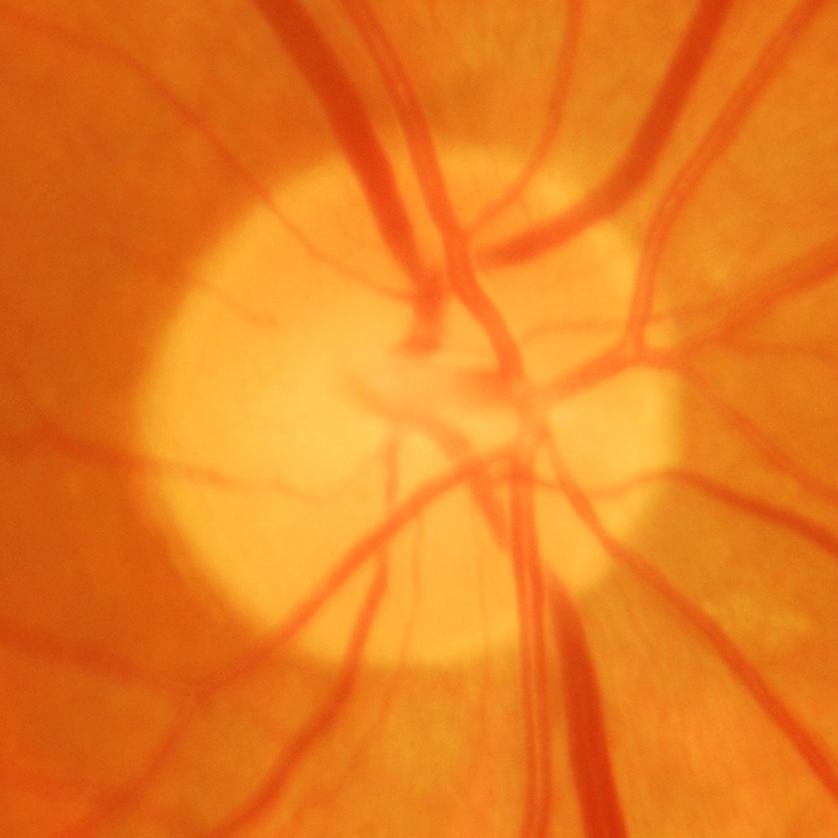

Demonstrates glaucomatous findings.